50° field of view. Posterior pole view: 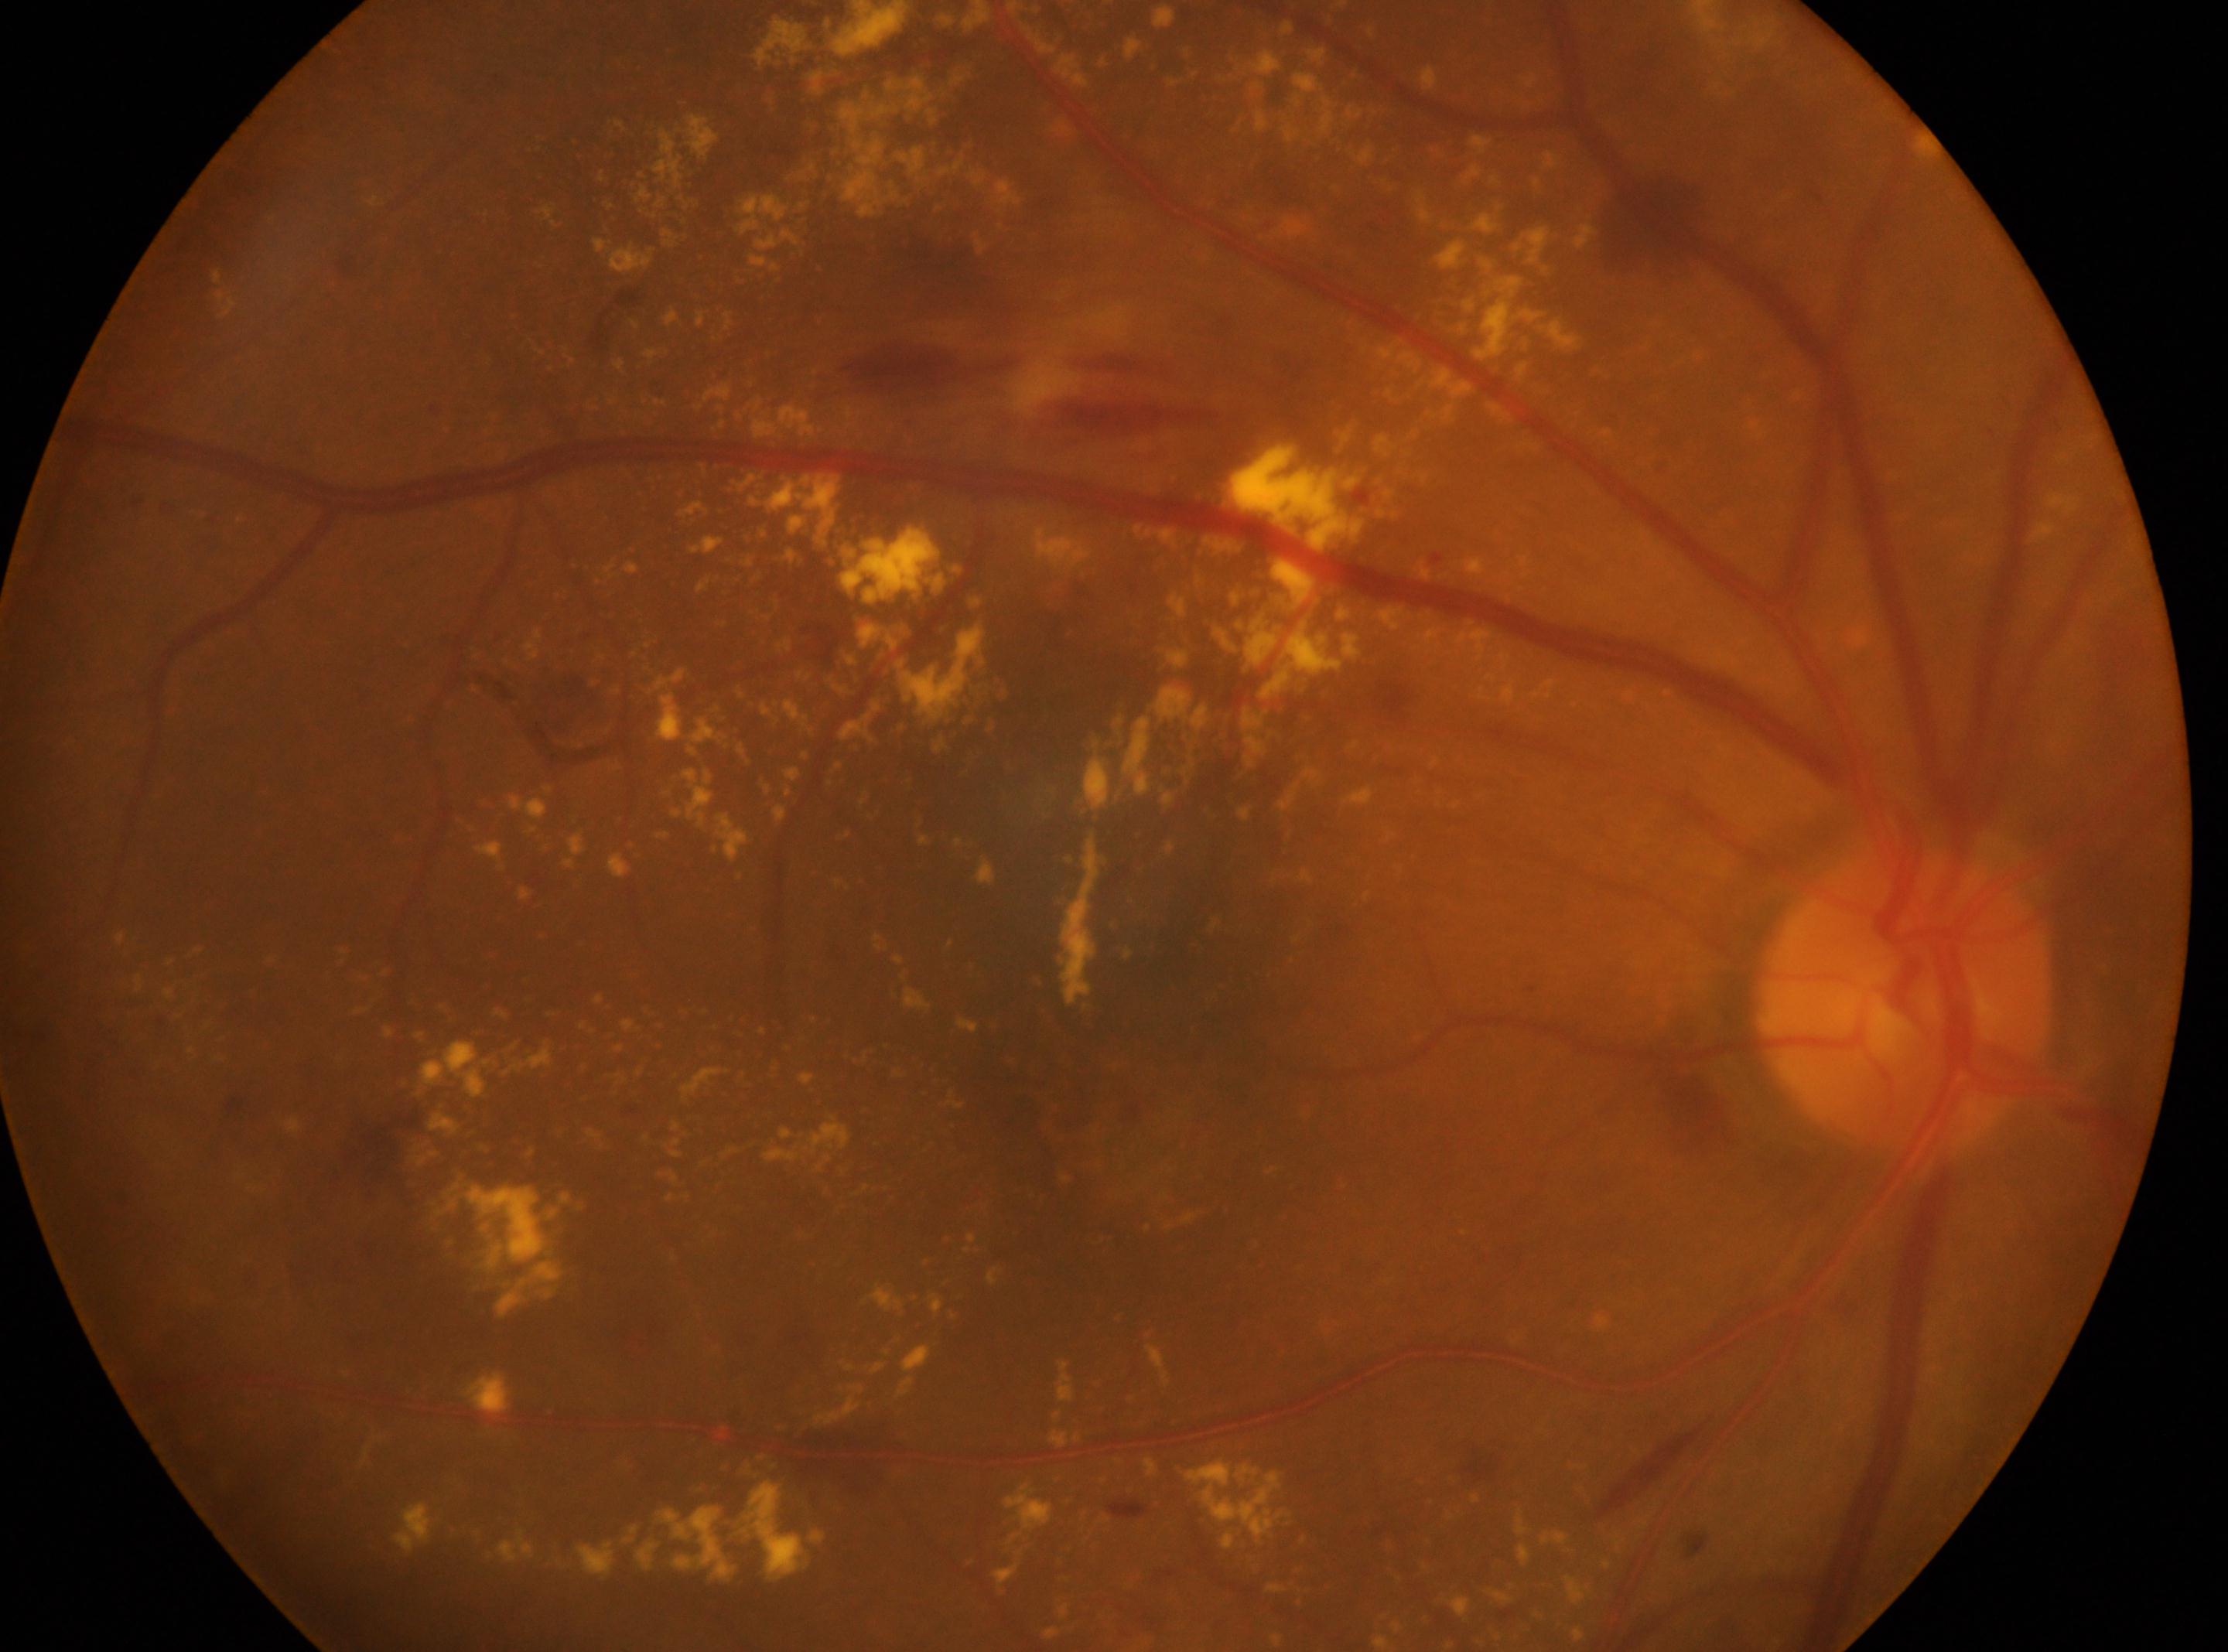

Imaged eye: OD. The fovea center is at [1116, 1080]. The optic disk is at [1902, 1001]. DR stage is 2.